Non-mydriatic acquisition; captured on a Nidek AFC-330 fundus camera
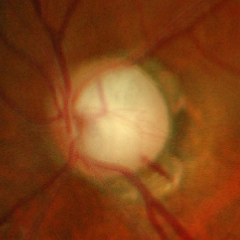
Q: What is the glaucoma diagnosis?
A: Yes — advanced-stage glaucoma. Defined as near-total cupping of the optic nerve head, with or without severe visual field loss within the central 10 degrees of fixation.